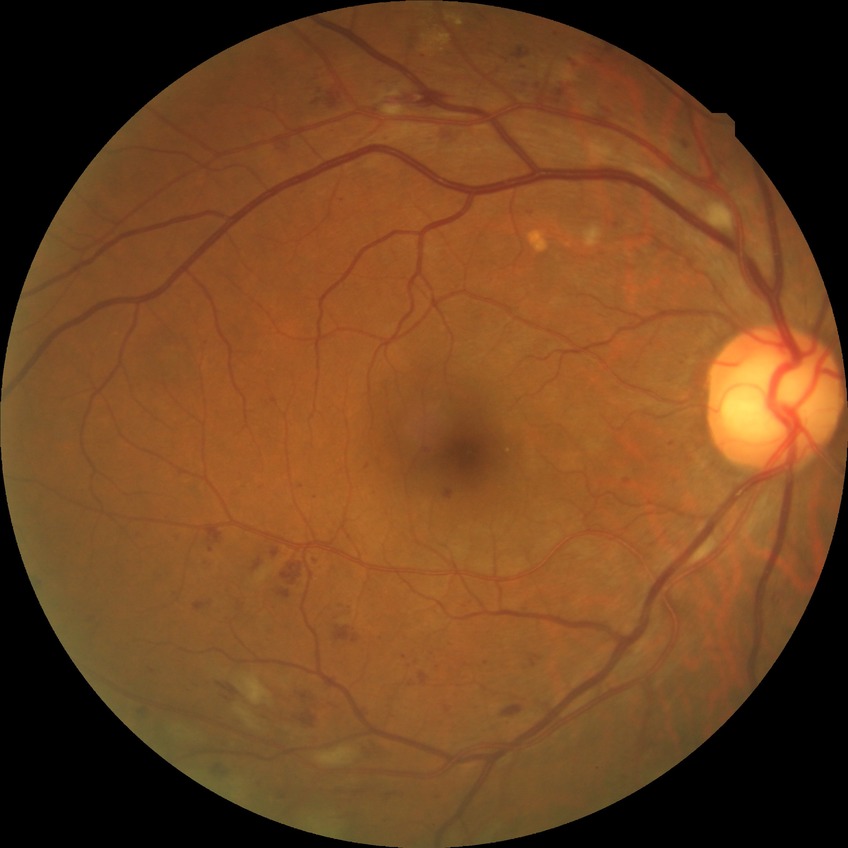 Diabetic retinopathy (DR): PPDR (pre-proliferative diabetic retinopathy). Disease class: non-proliferative diabetic retinopathy.